Without pupil dilation. FOV: 45 degrees. Camera: NIDEK AFC-230. Posterior pole color fundus photograph.
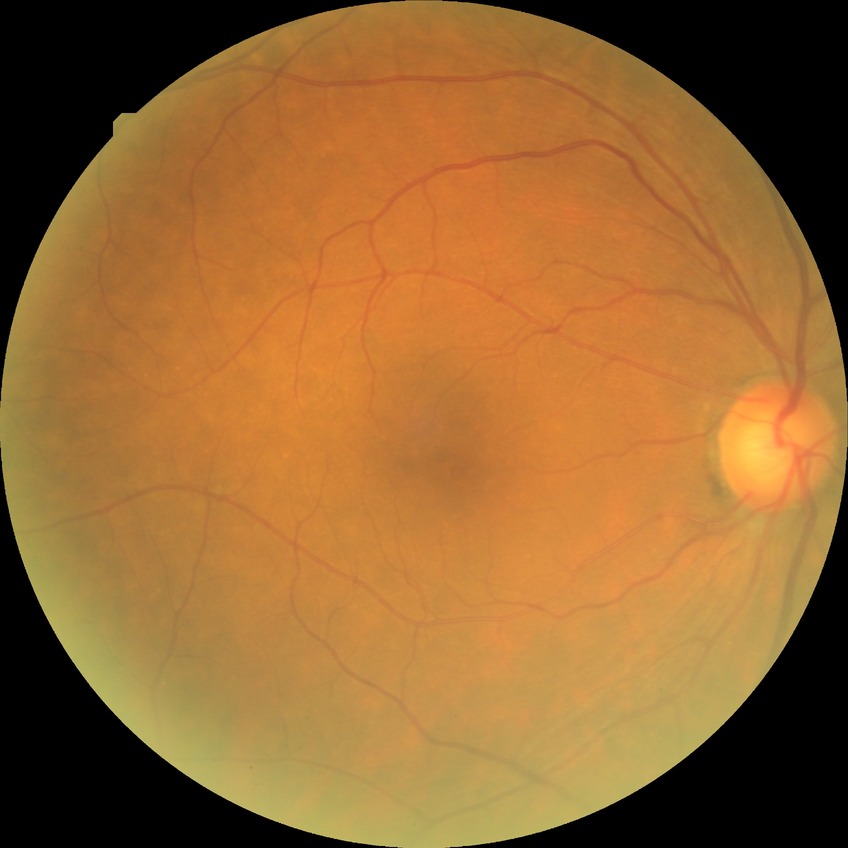 {
  "dr_impression": "no DR findings",
  "davis_grade": "NDR"
}